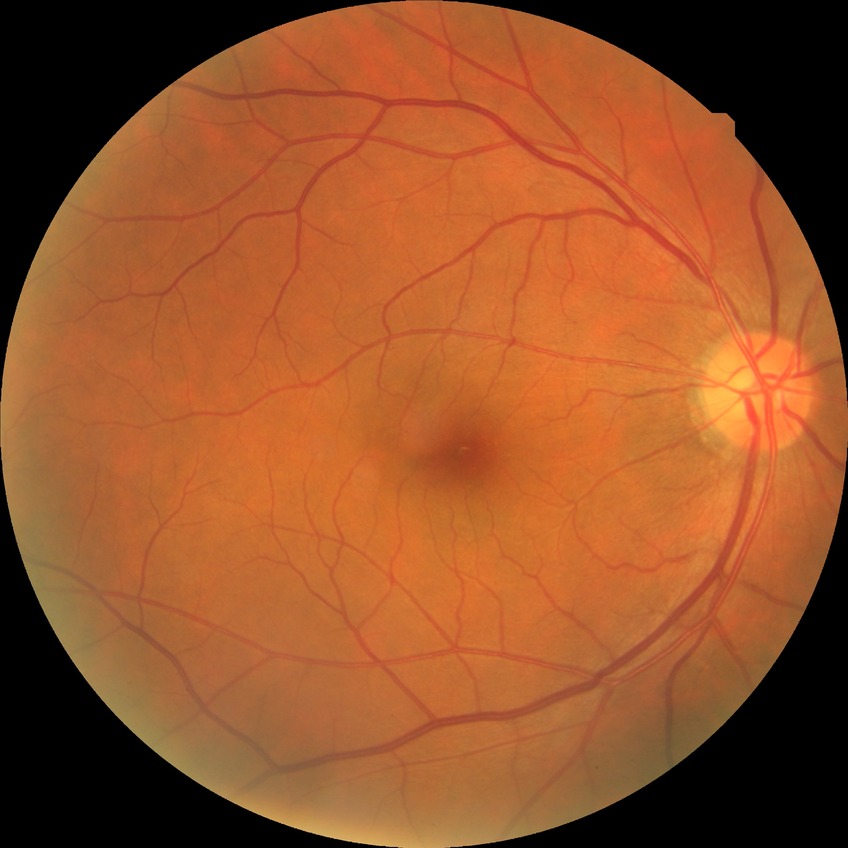
diabetic retinopathy (DR): no diabetic retinopathy (NDR).